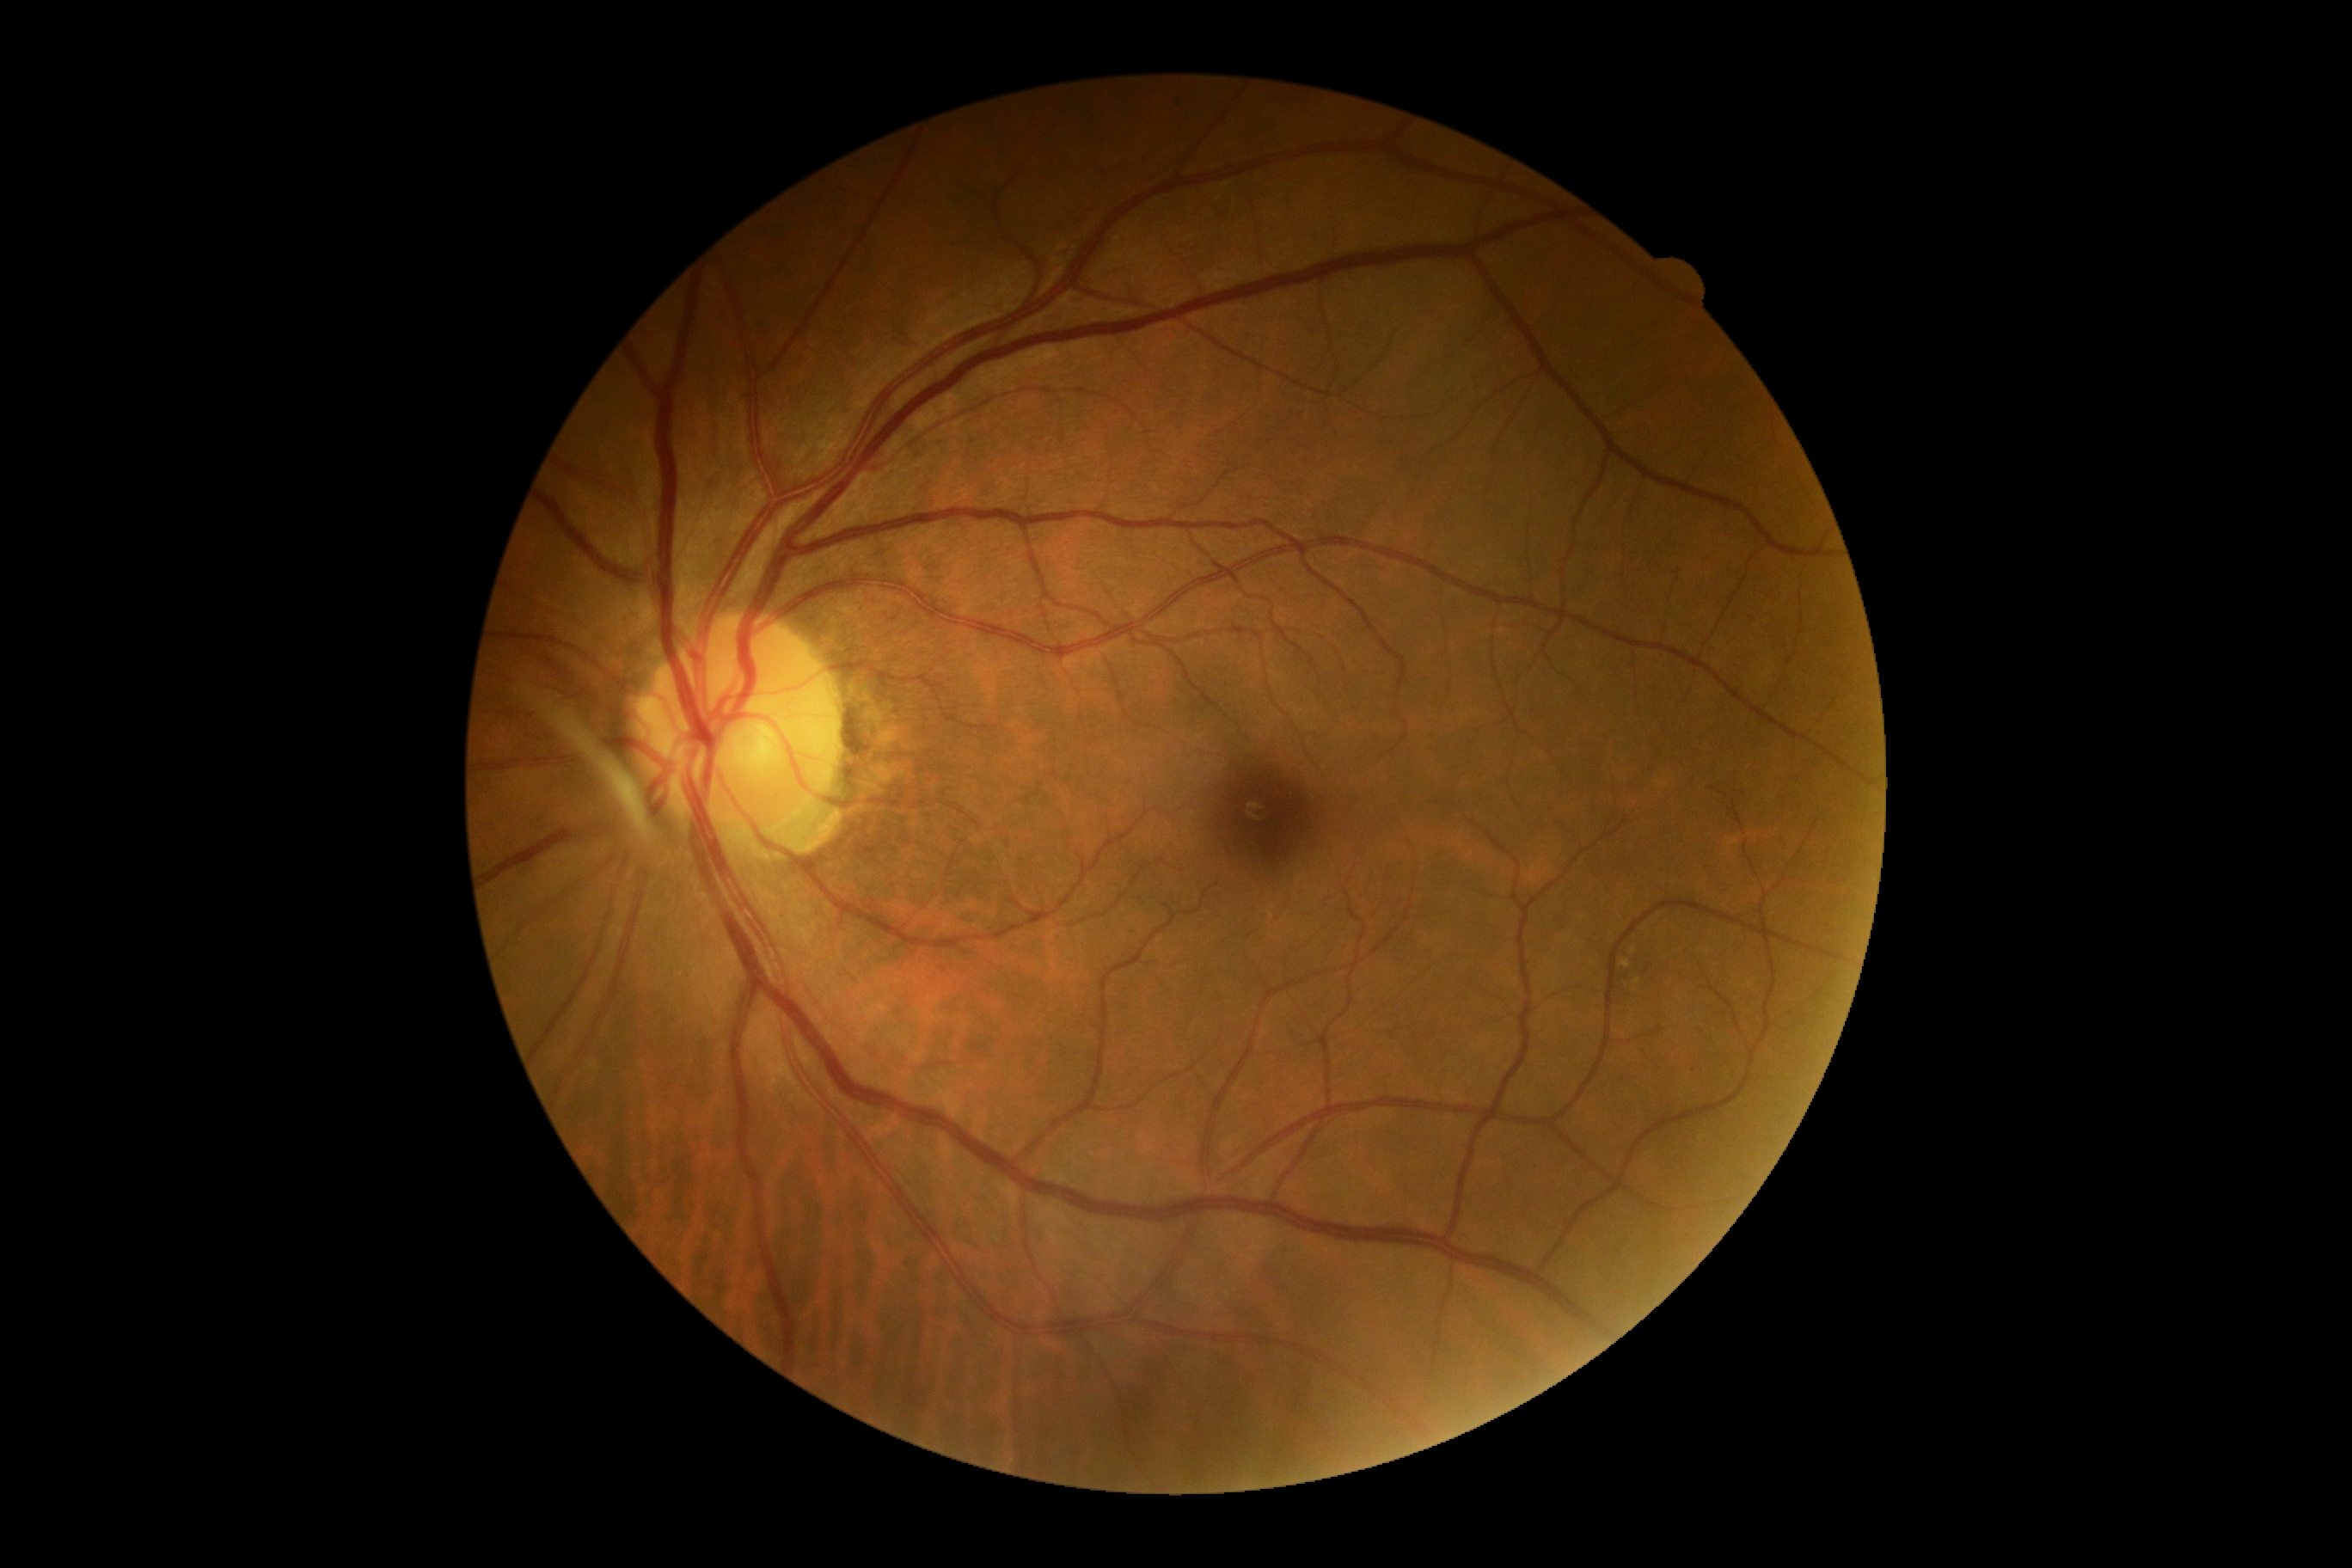
DR stage: grade 0 (no apparent retinopathy).